Color fundus image.
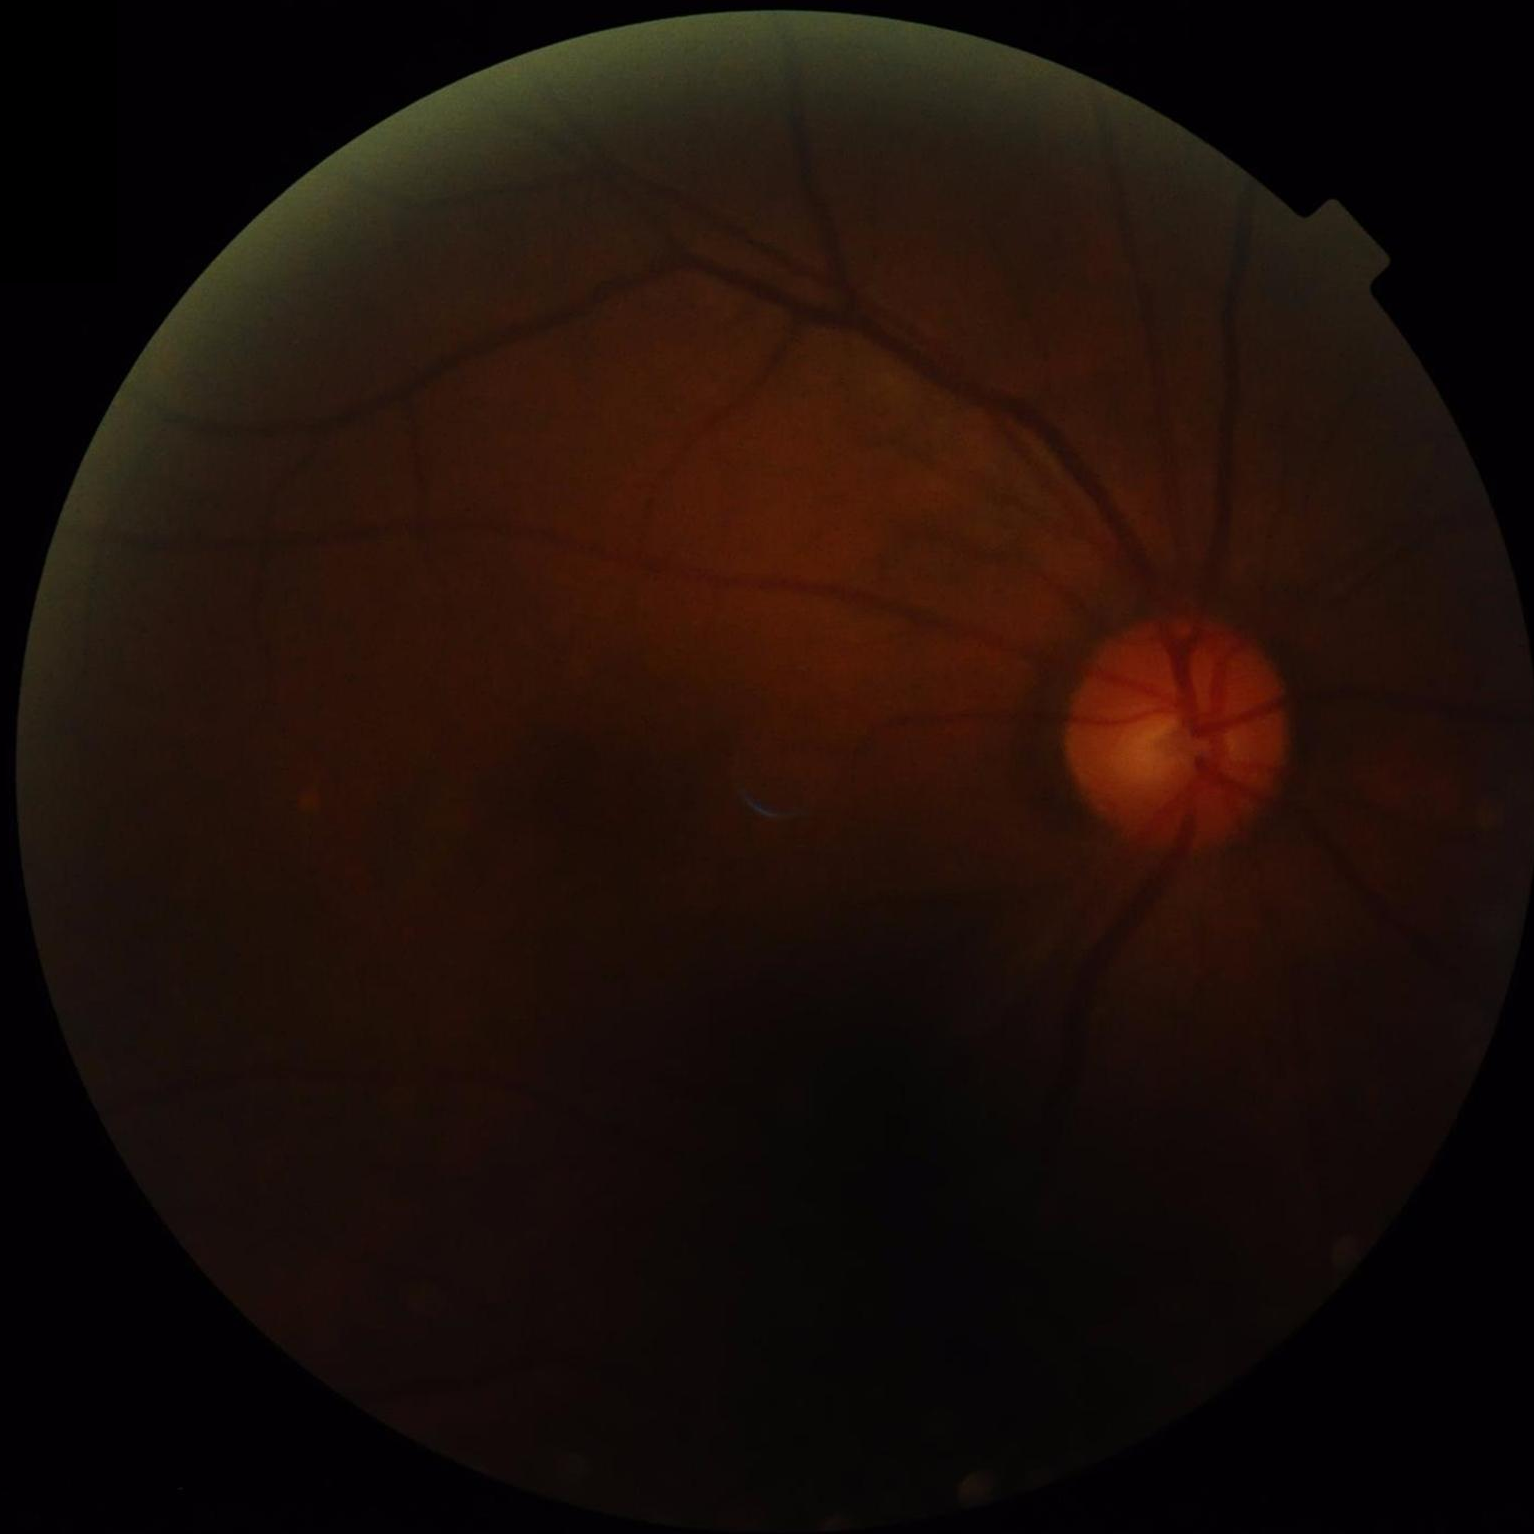 Vessels and details are hard to distinguish. Overall image quality is poor. Illumination is uneven. Optic disc, vessels, and background are in focus.